1240x1240; acquired on the Phoenix ICON; infant wide-field retinal image — 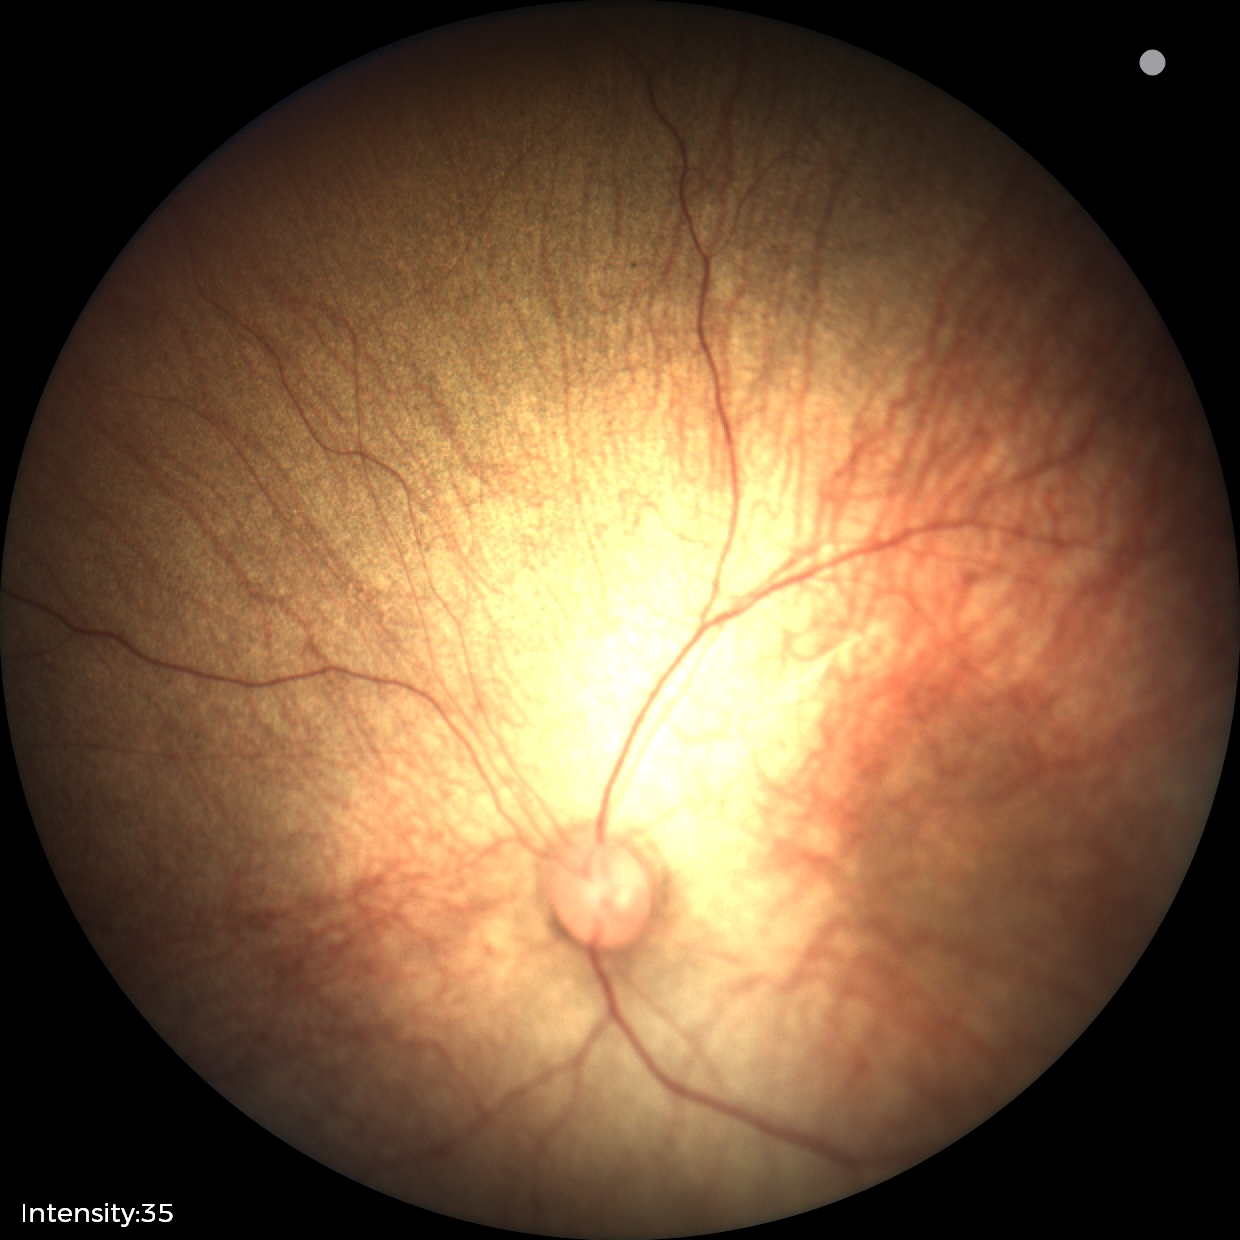 Assessment: normal fundus examination.